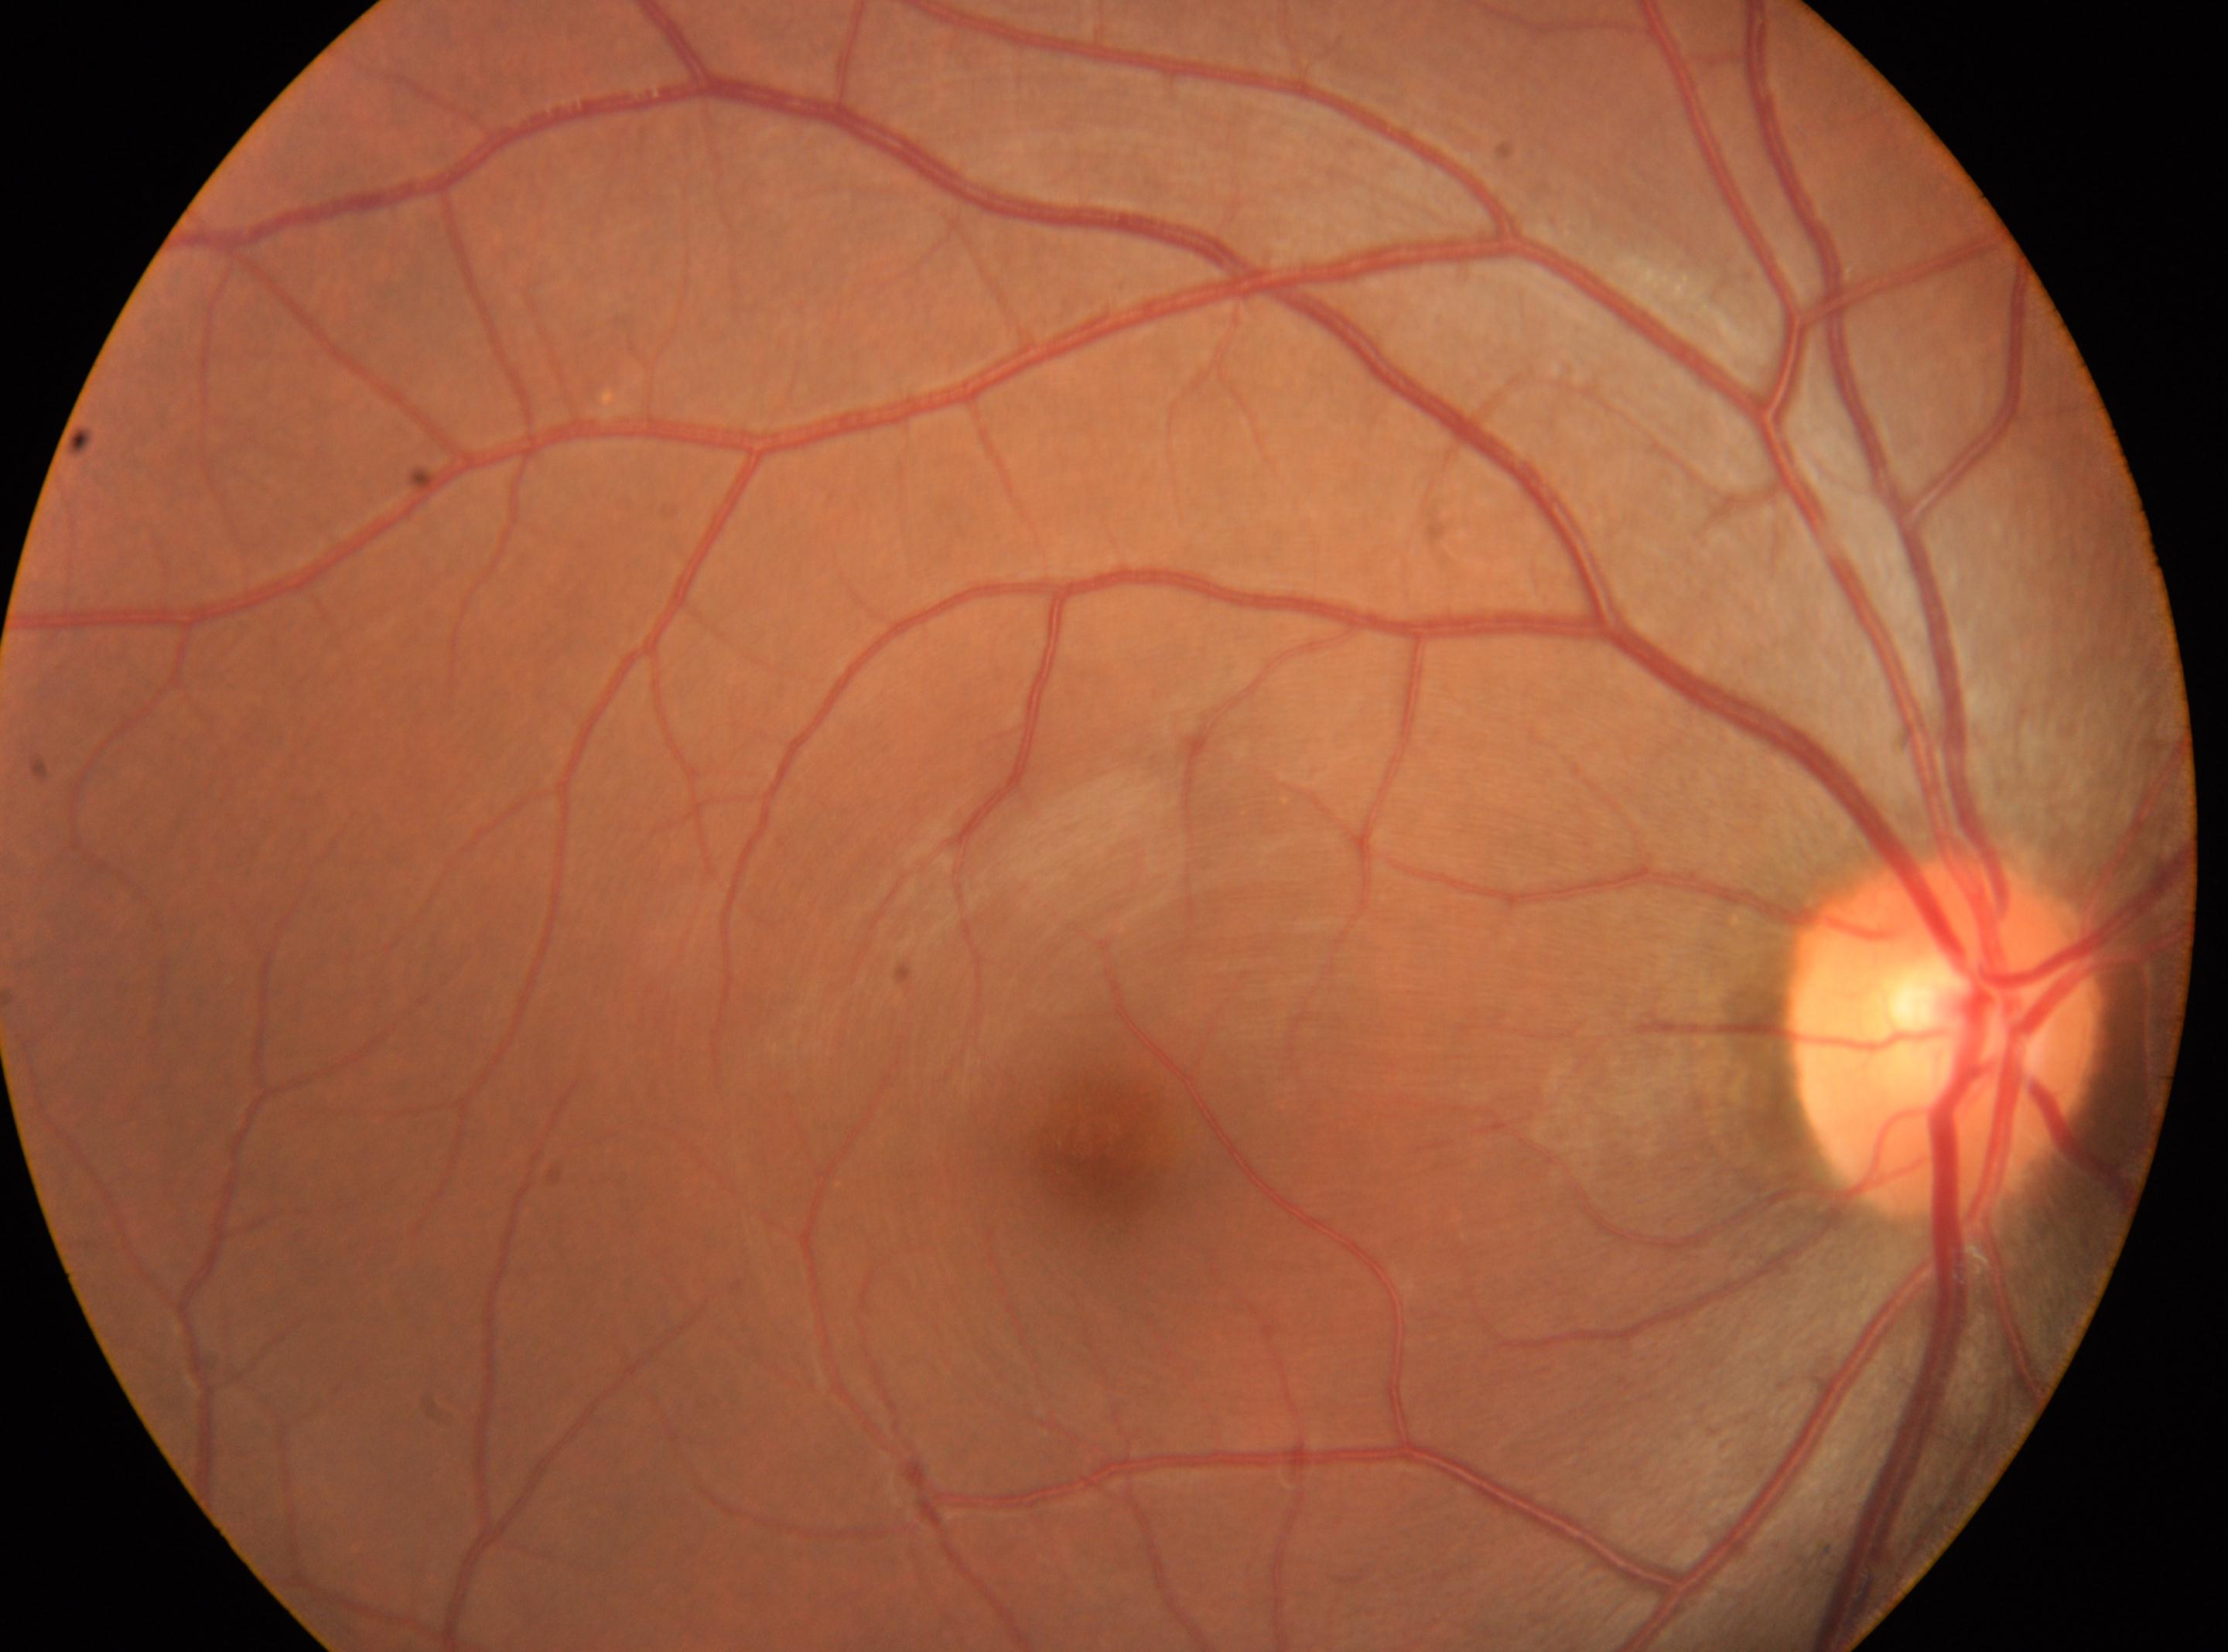 {"eye": "right", "dr_grade": "0/4", "optic_disc": "x=1943, y=1035", "fovea": "x=1100, y=1142"}